848x848px · no pharmacologic dilation — 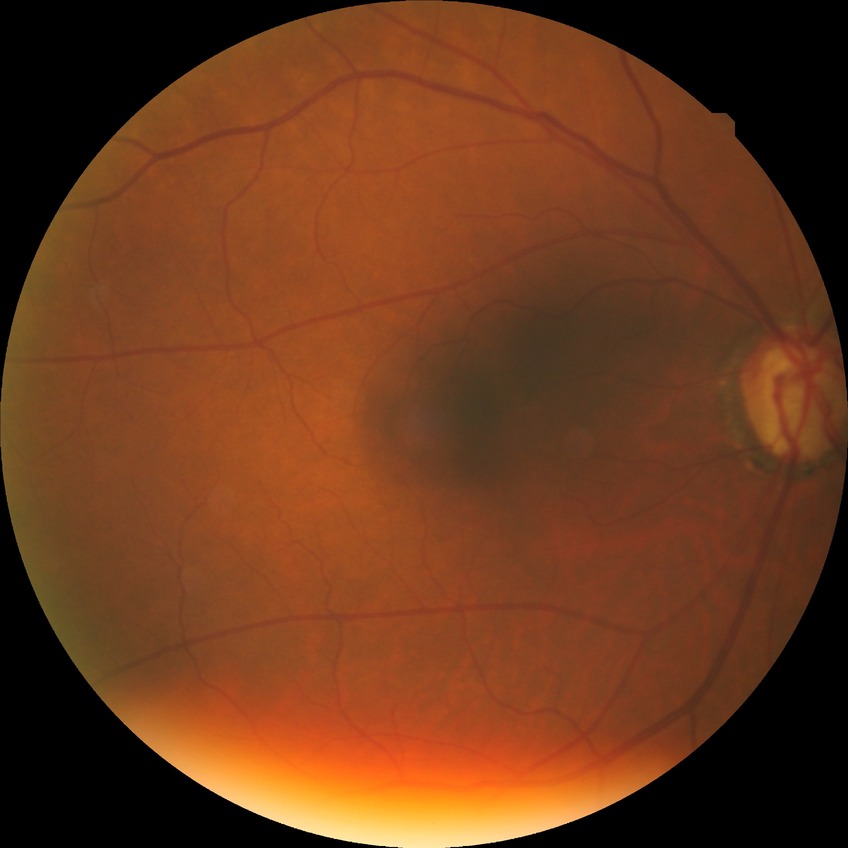
retinopathy stage: no diabetic retinopathy.